Image size 2102x1736
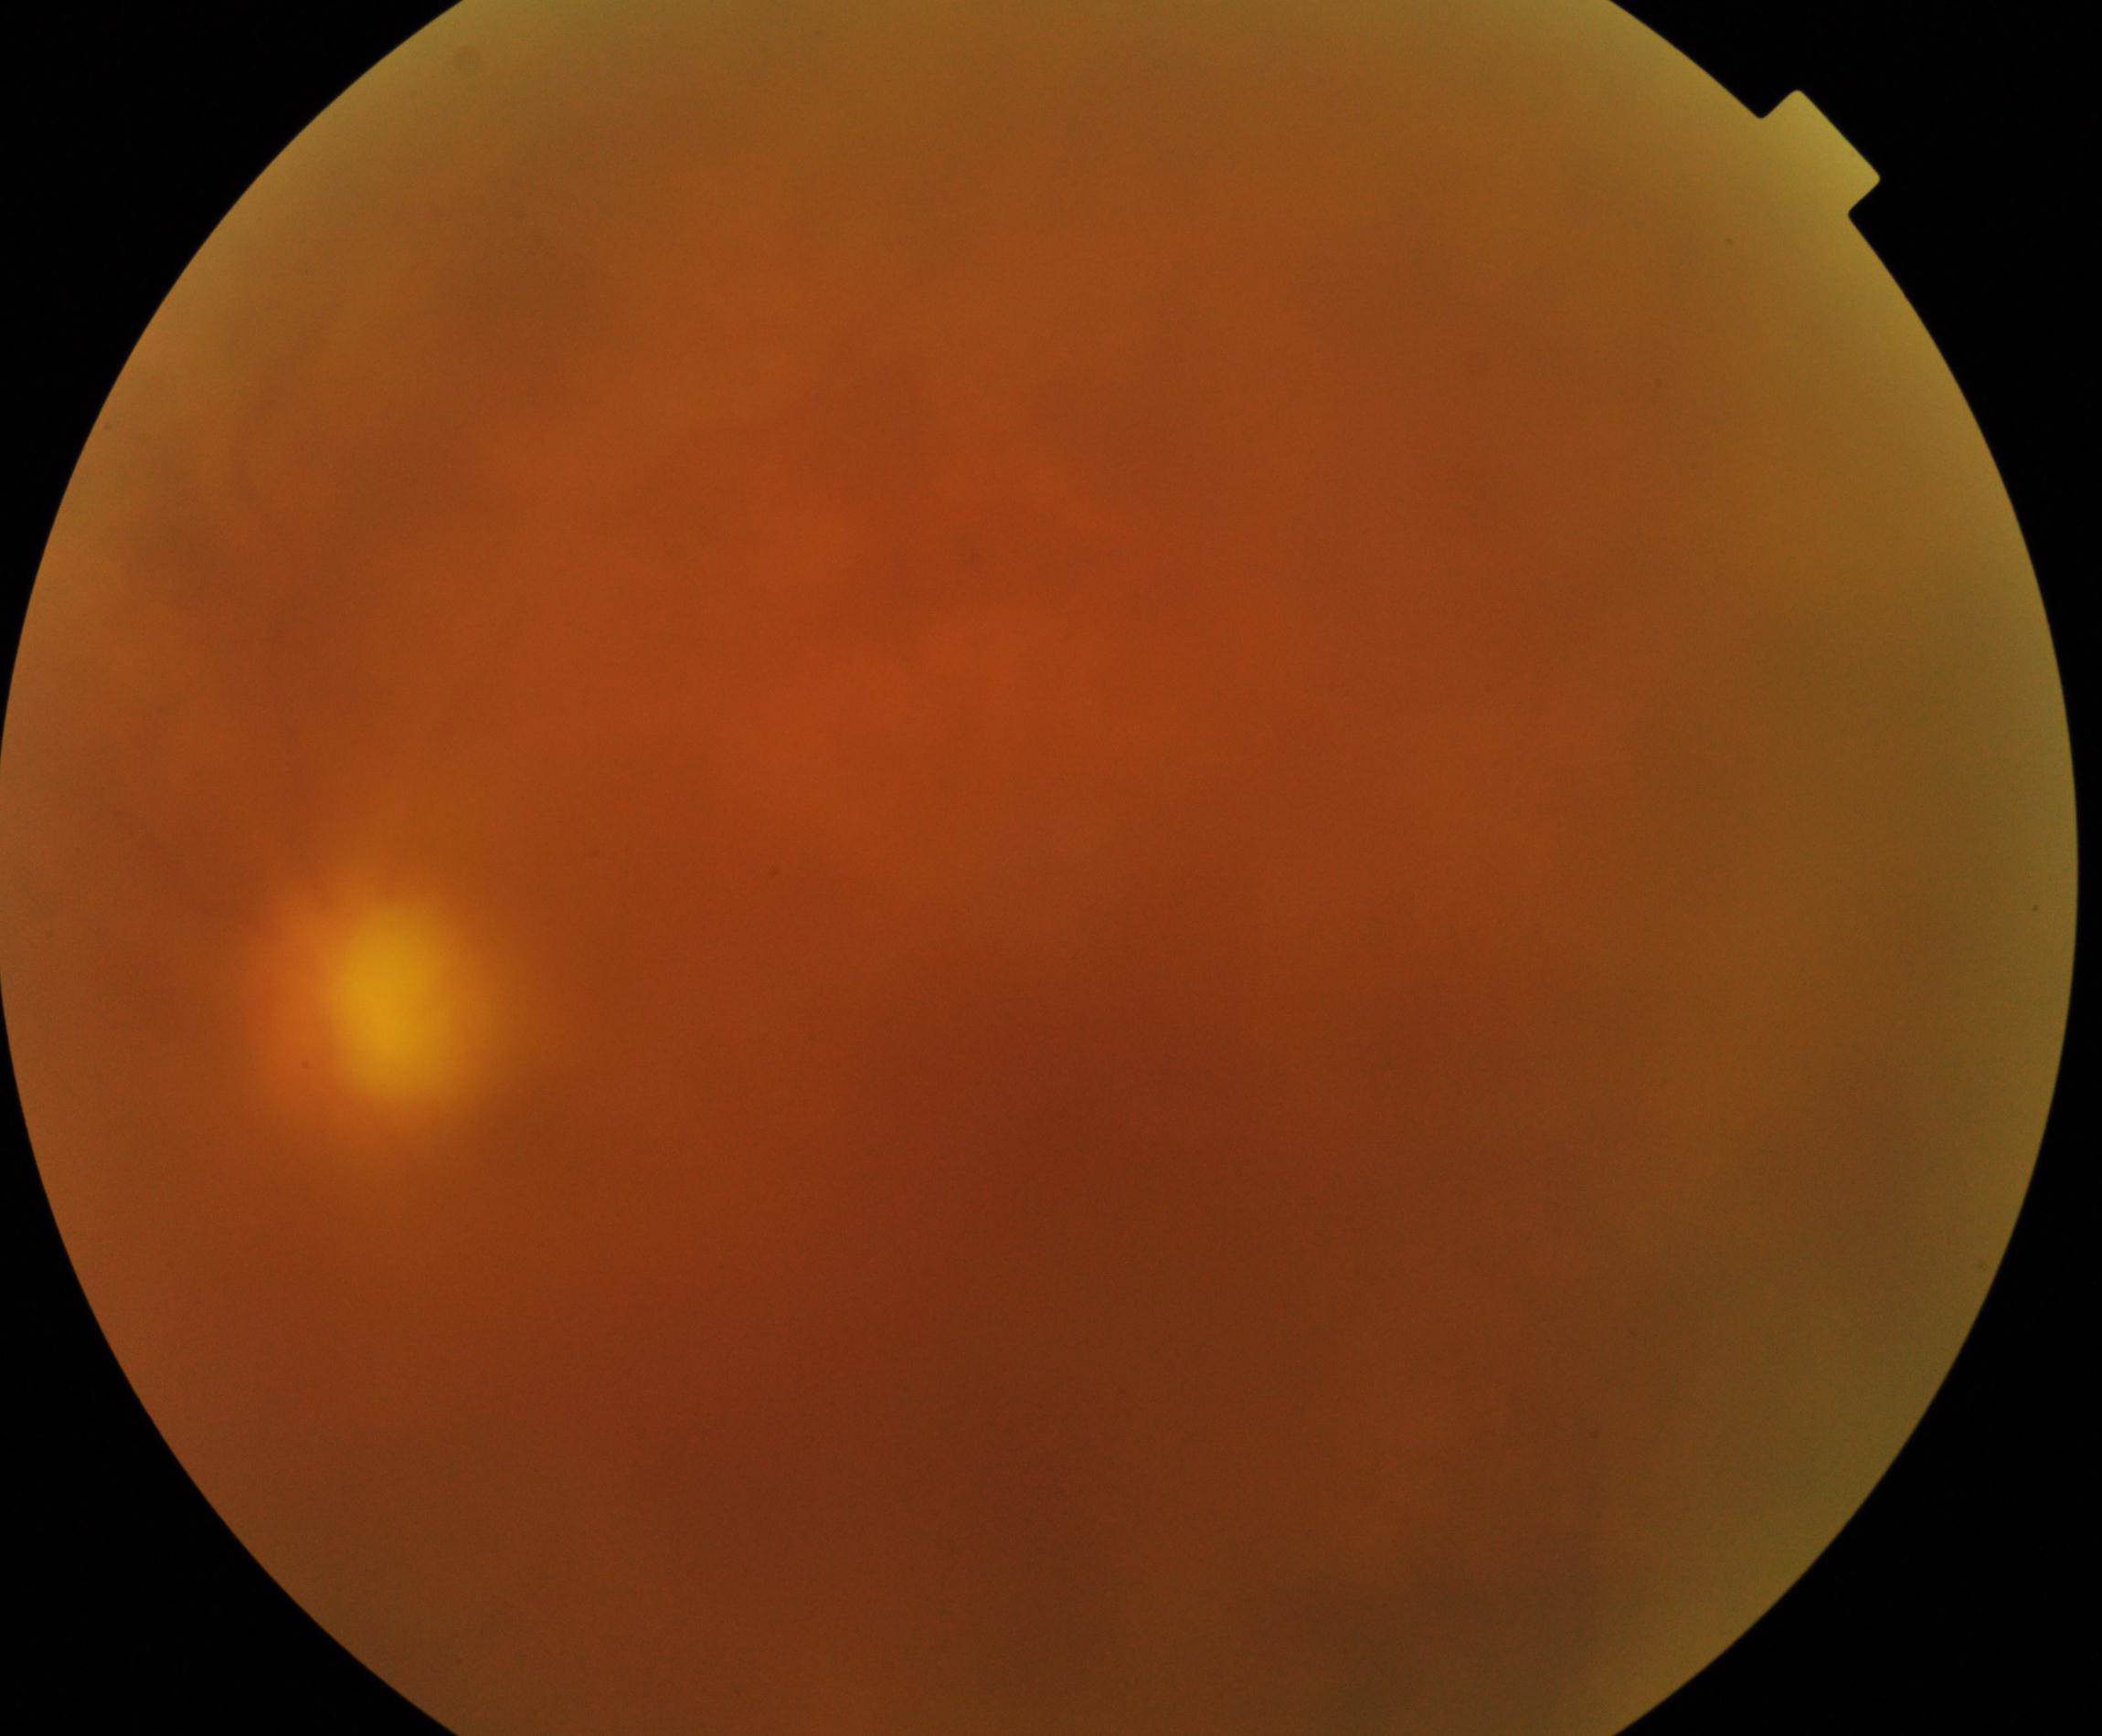 Image quality: poor.
Proliferative retinopathy: negative.